NIDEK AFC-230 fundus camera. 848x848. 45 degree fundus photograph. Without pupil dilation: 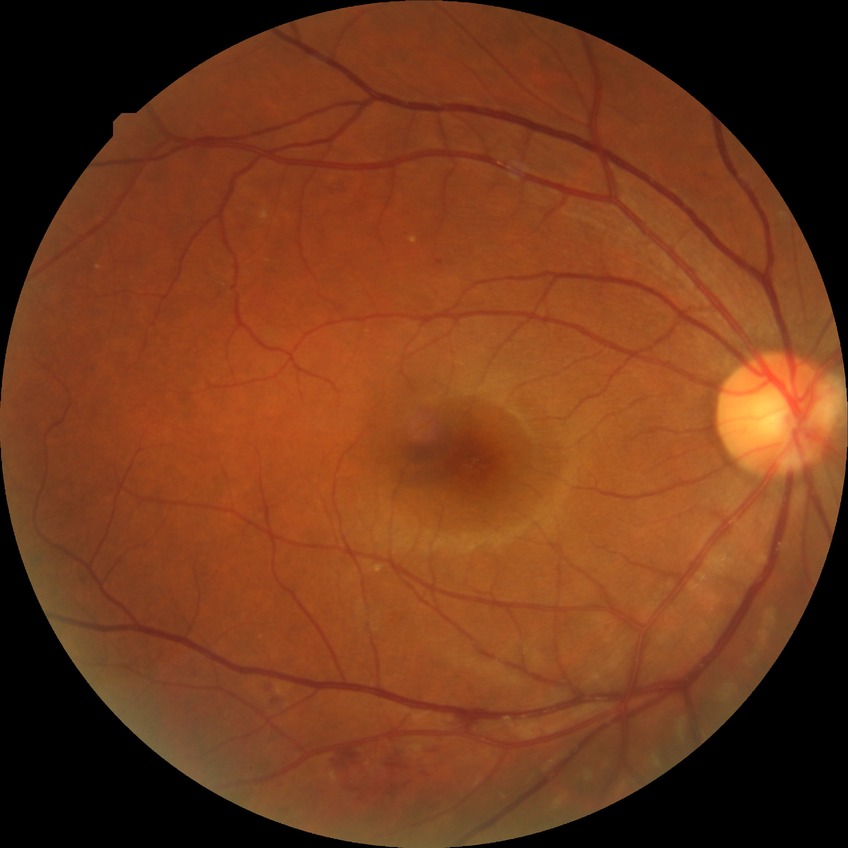

Findings:
– diabetic retinopathy (DR): SDR (simple diabetic retinopathy)